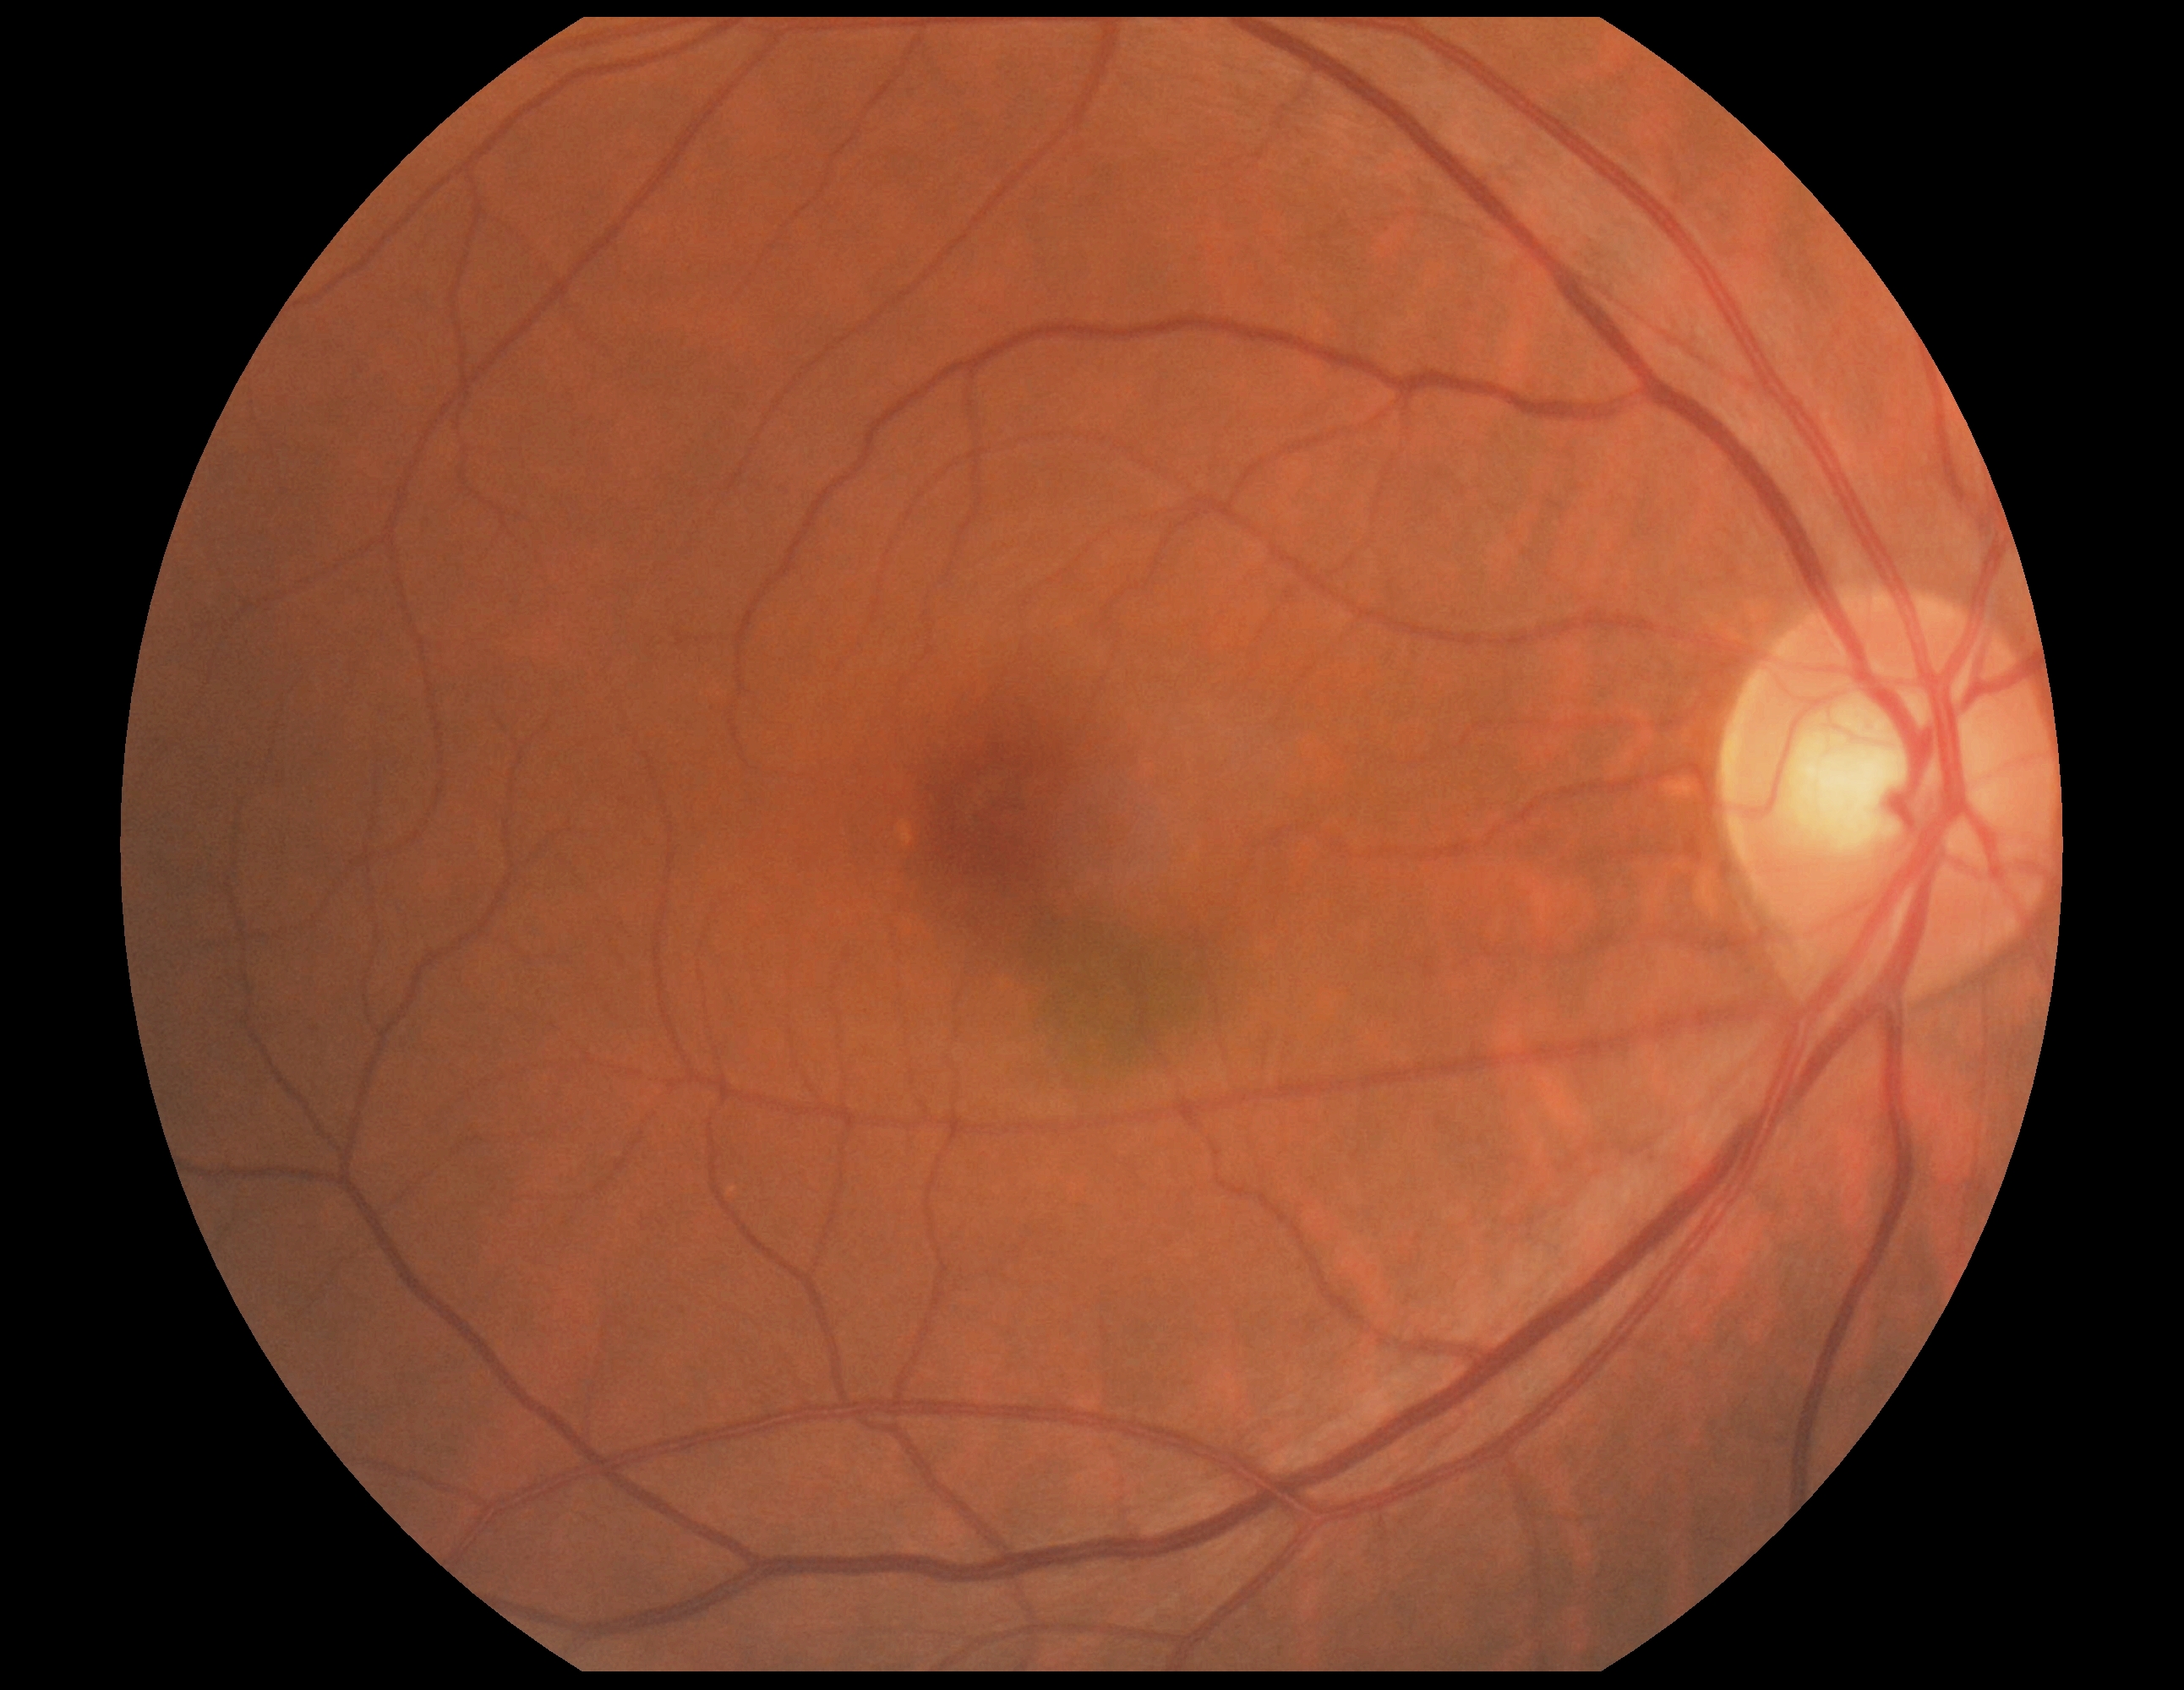 Retinopathy grade: 0 (no apparent retinopathy).
No apparent diabetic retinopathy.